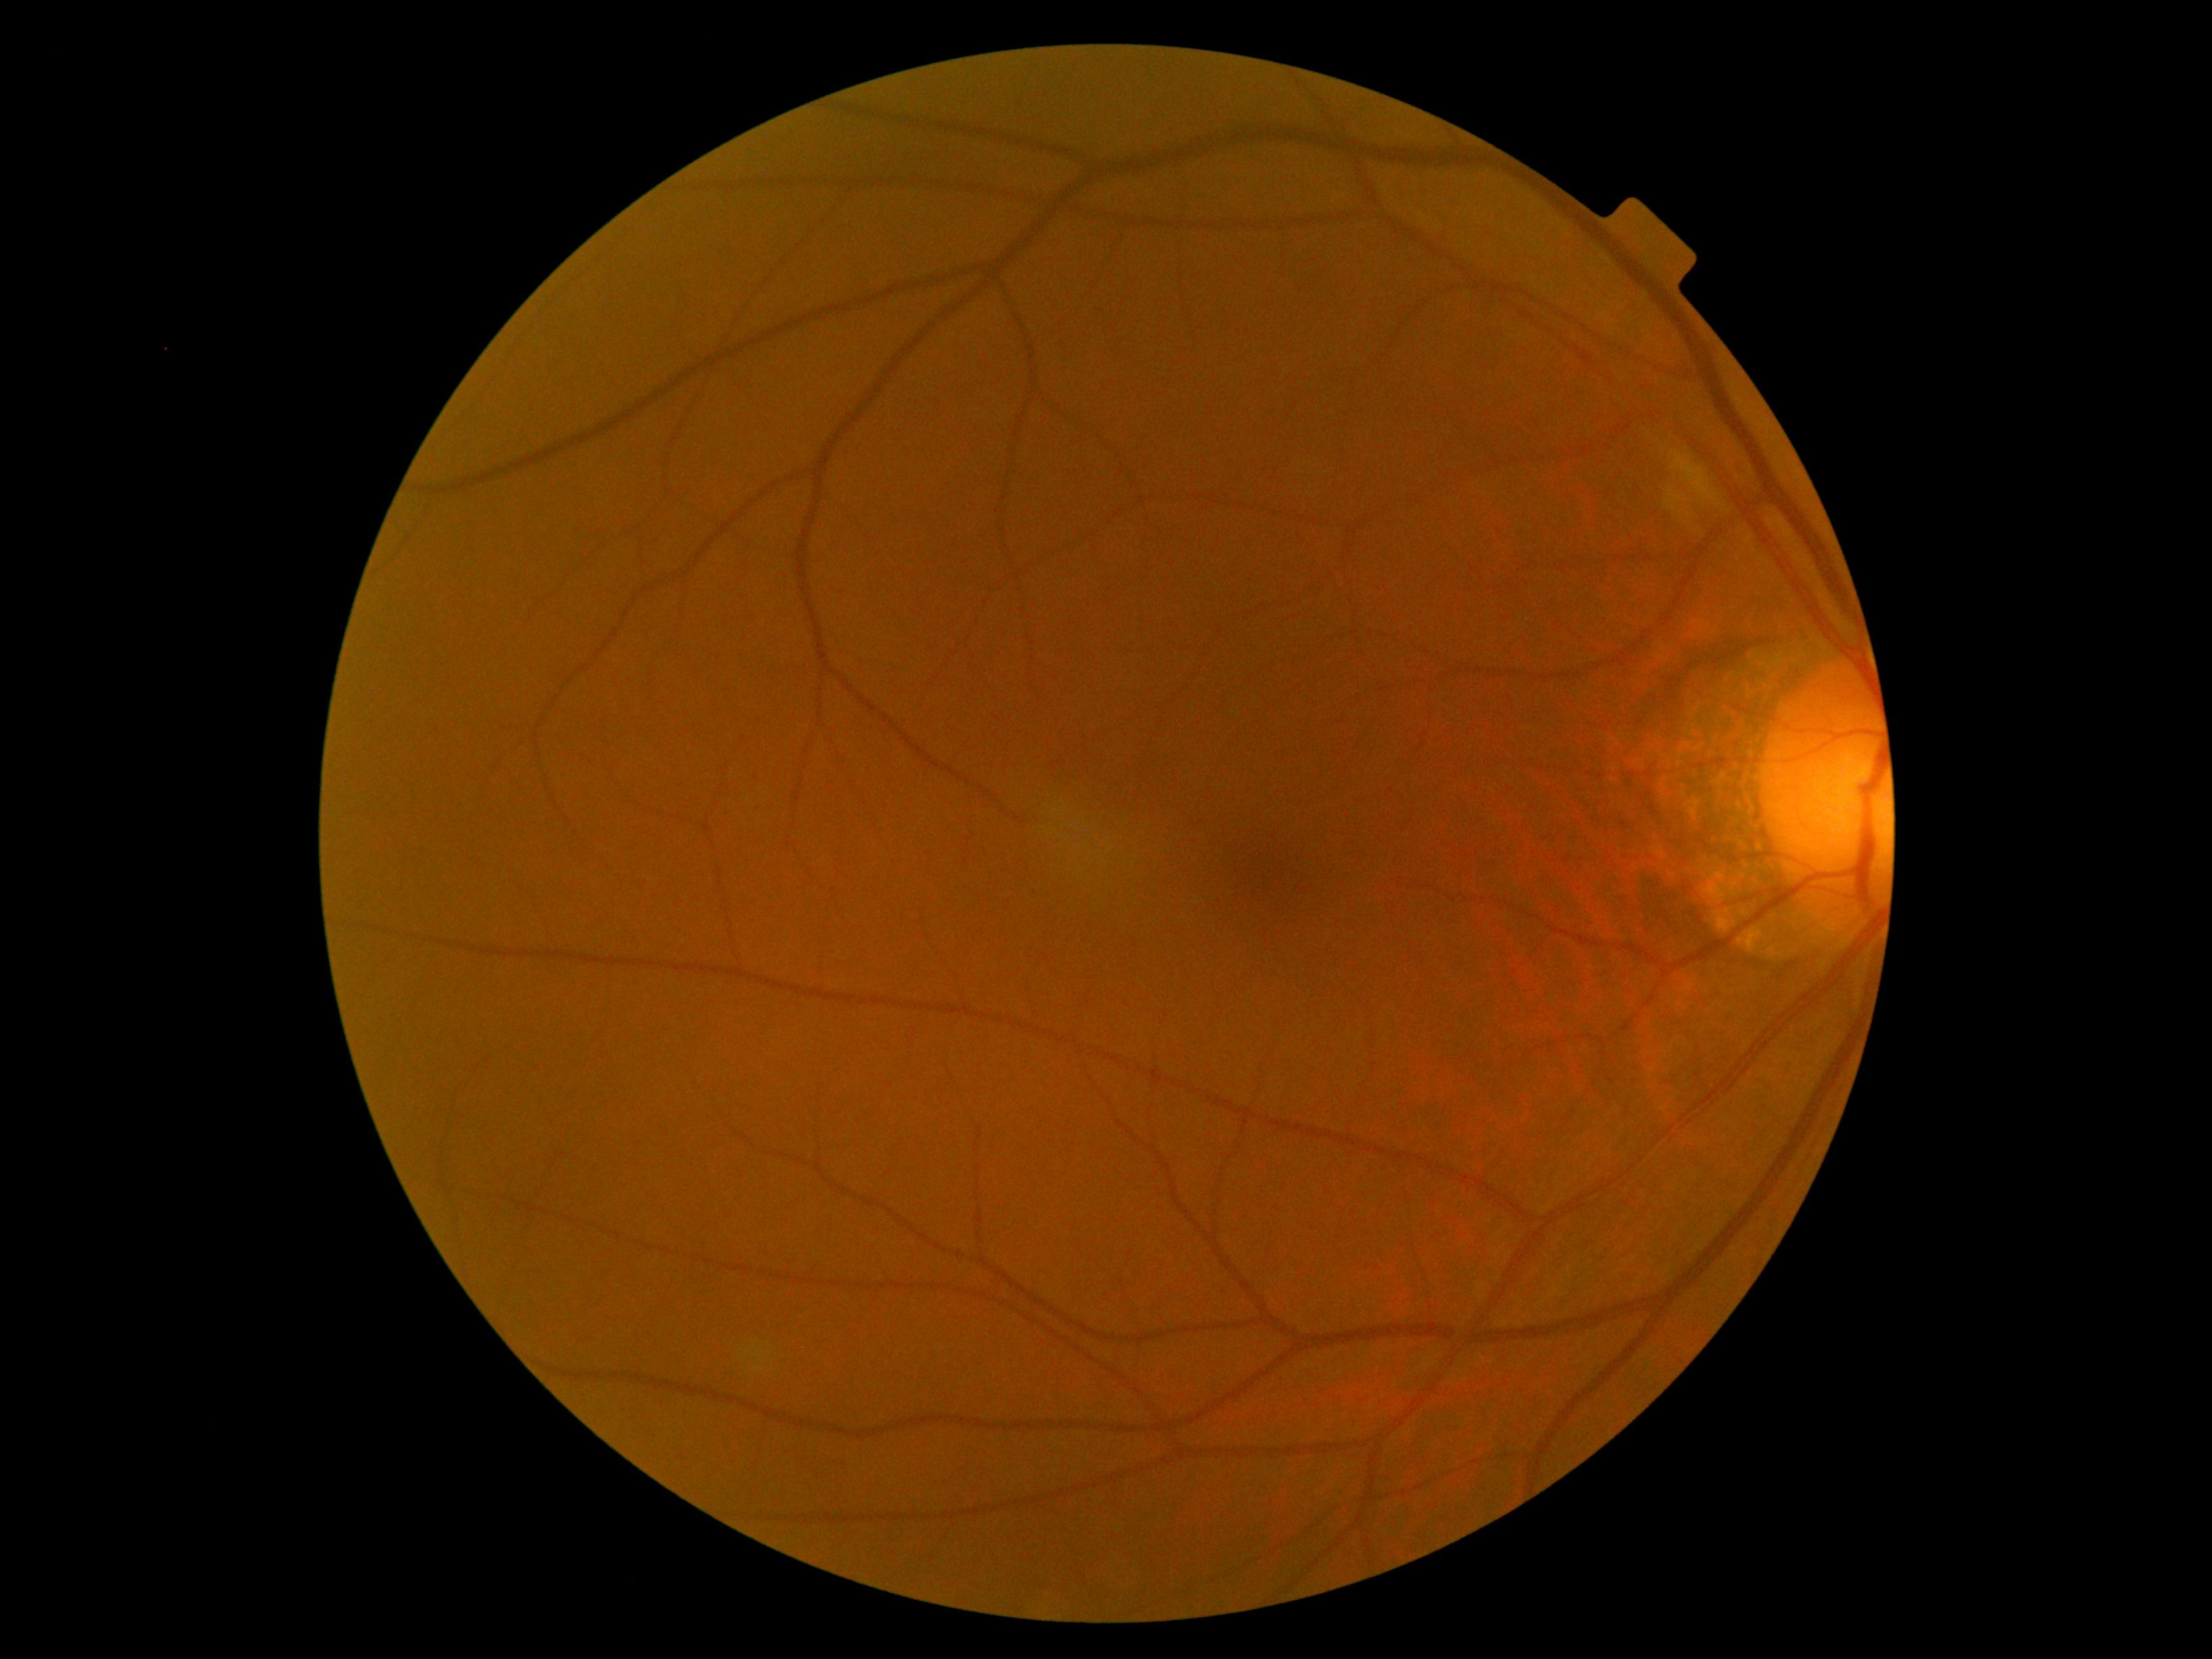
Diabetic retinopathy is moderate NPDR (grade 2) — more than just microaneurysms but less than severe NPDR. The retinopathy is classified as non-proliferative diabetic retinopathy.